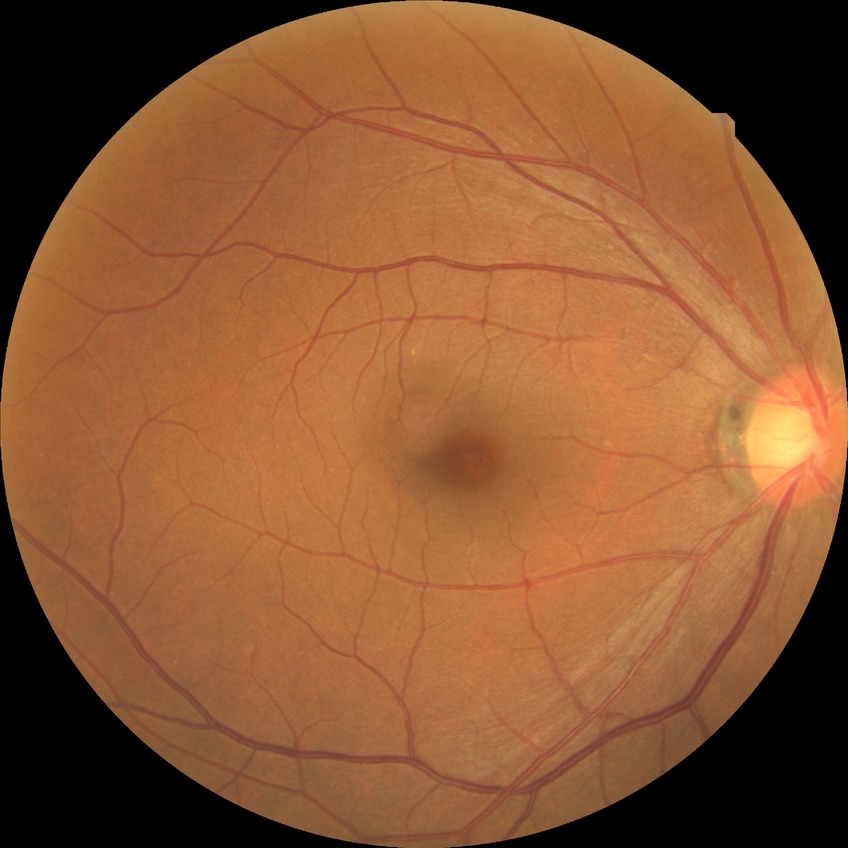
Davis stage: SDR.